Infant wide-field fundus photograph. 1240 by 1240 pixels
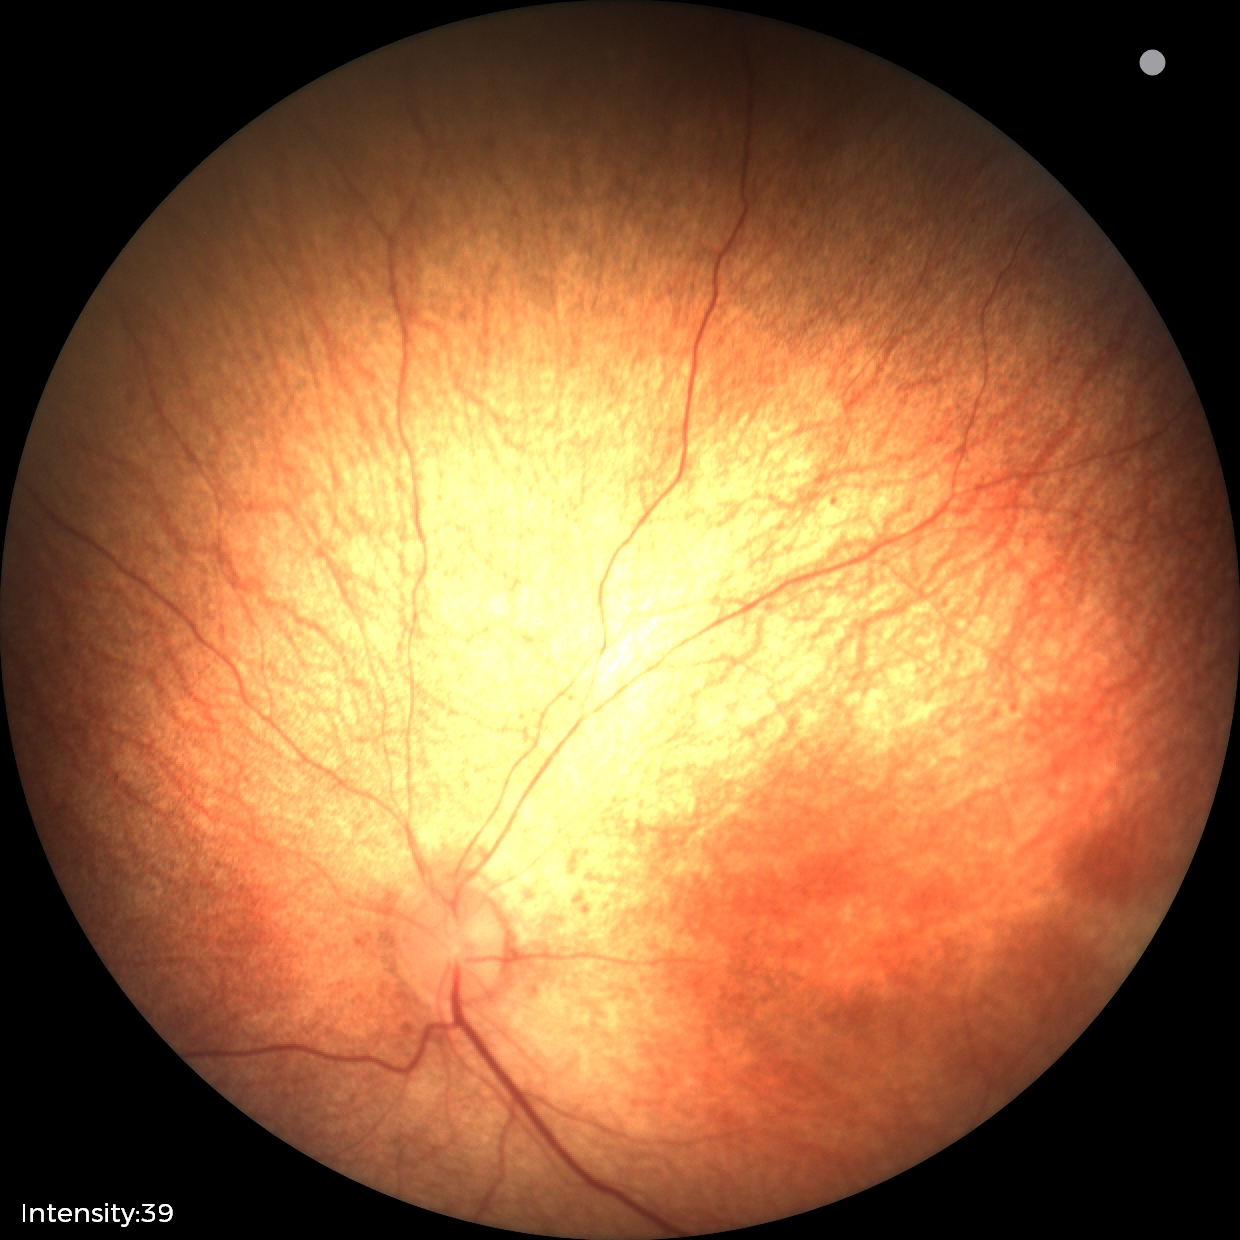 Q: What was the screening finding?
A: normal fundus examination